Fundus photo:
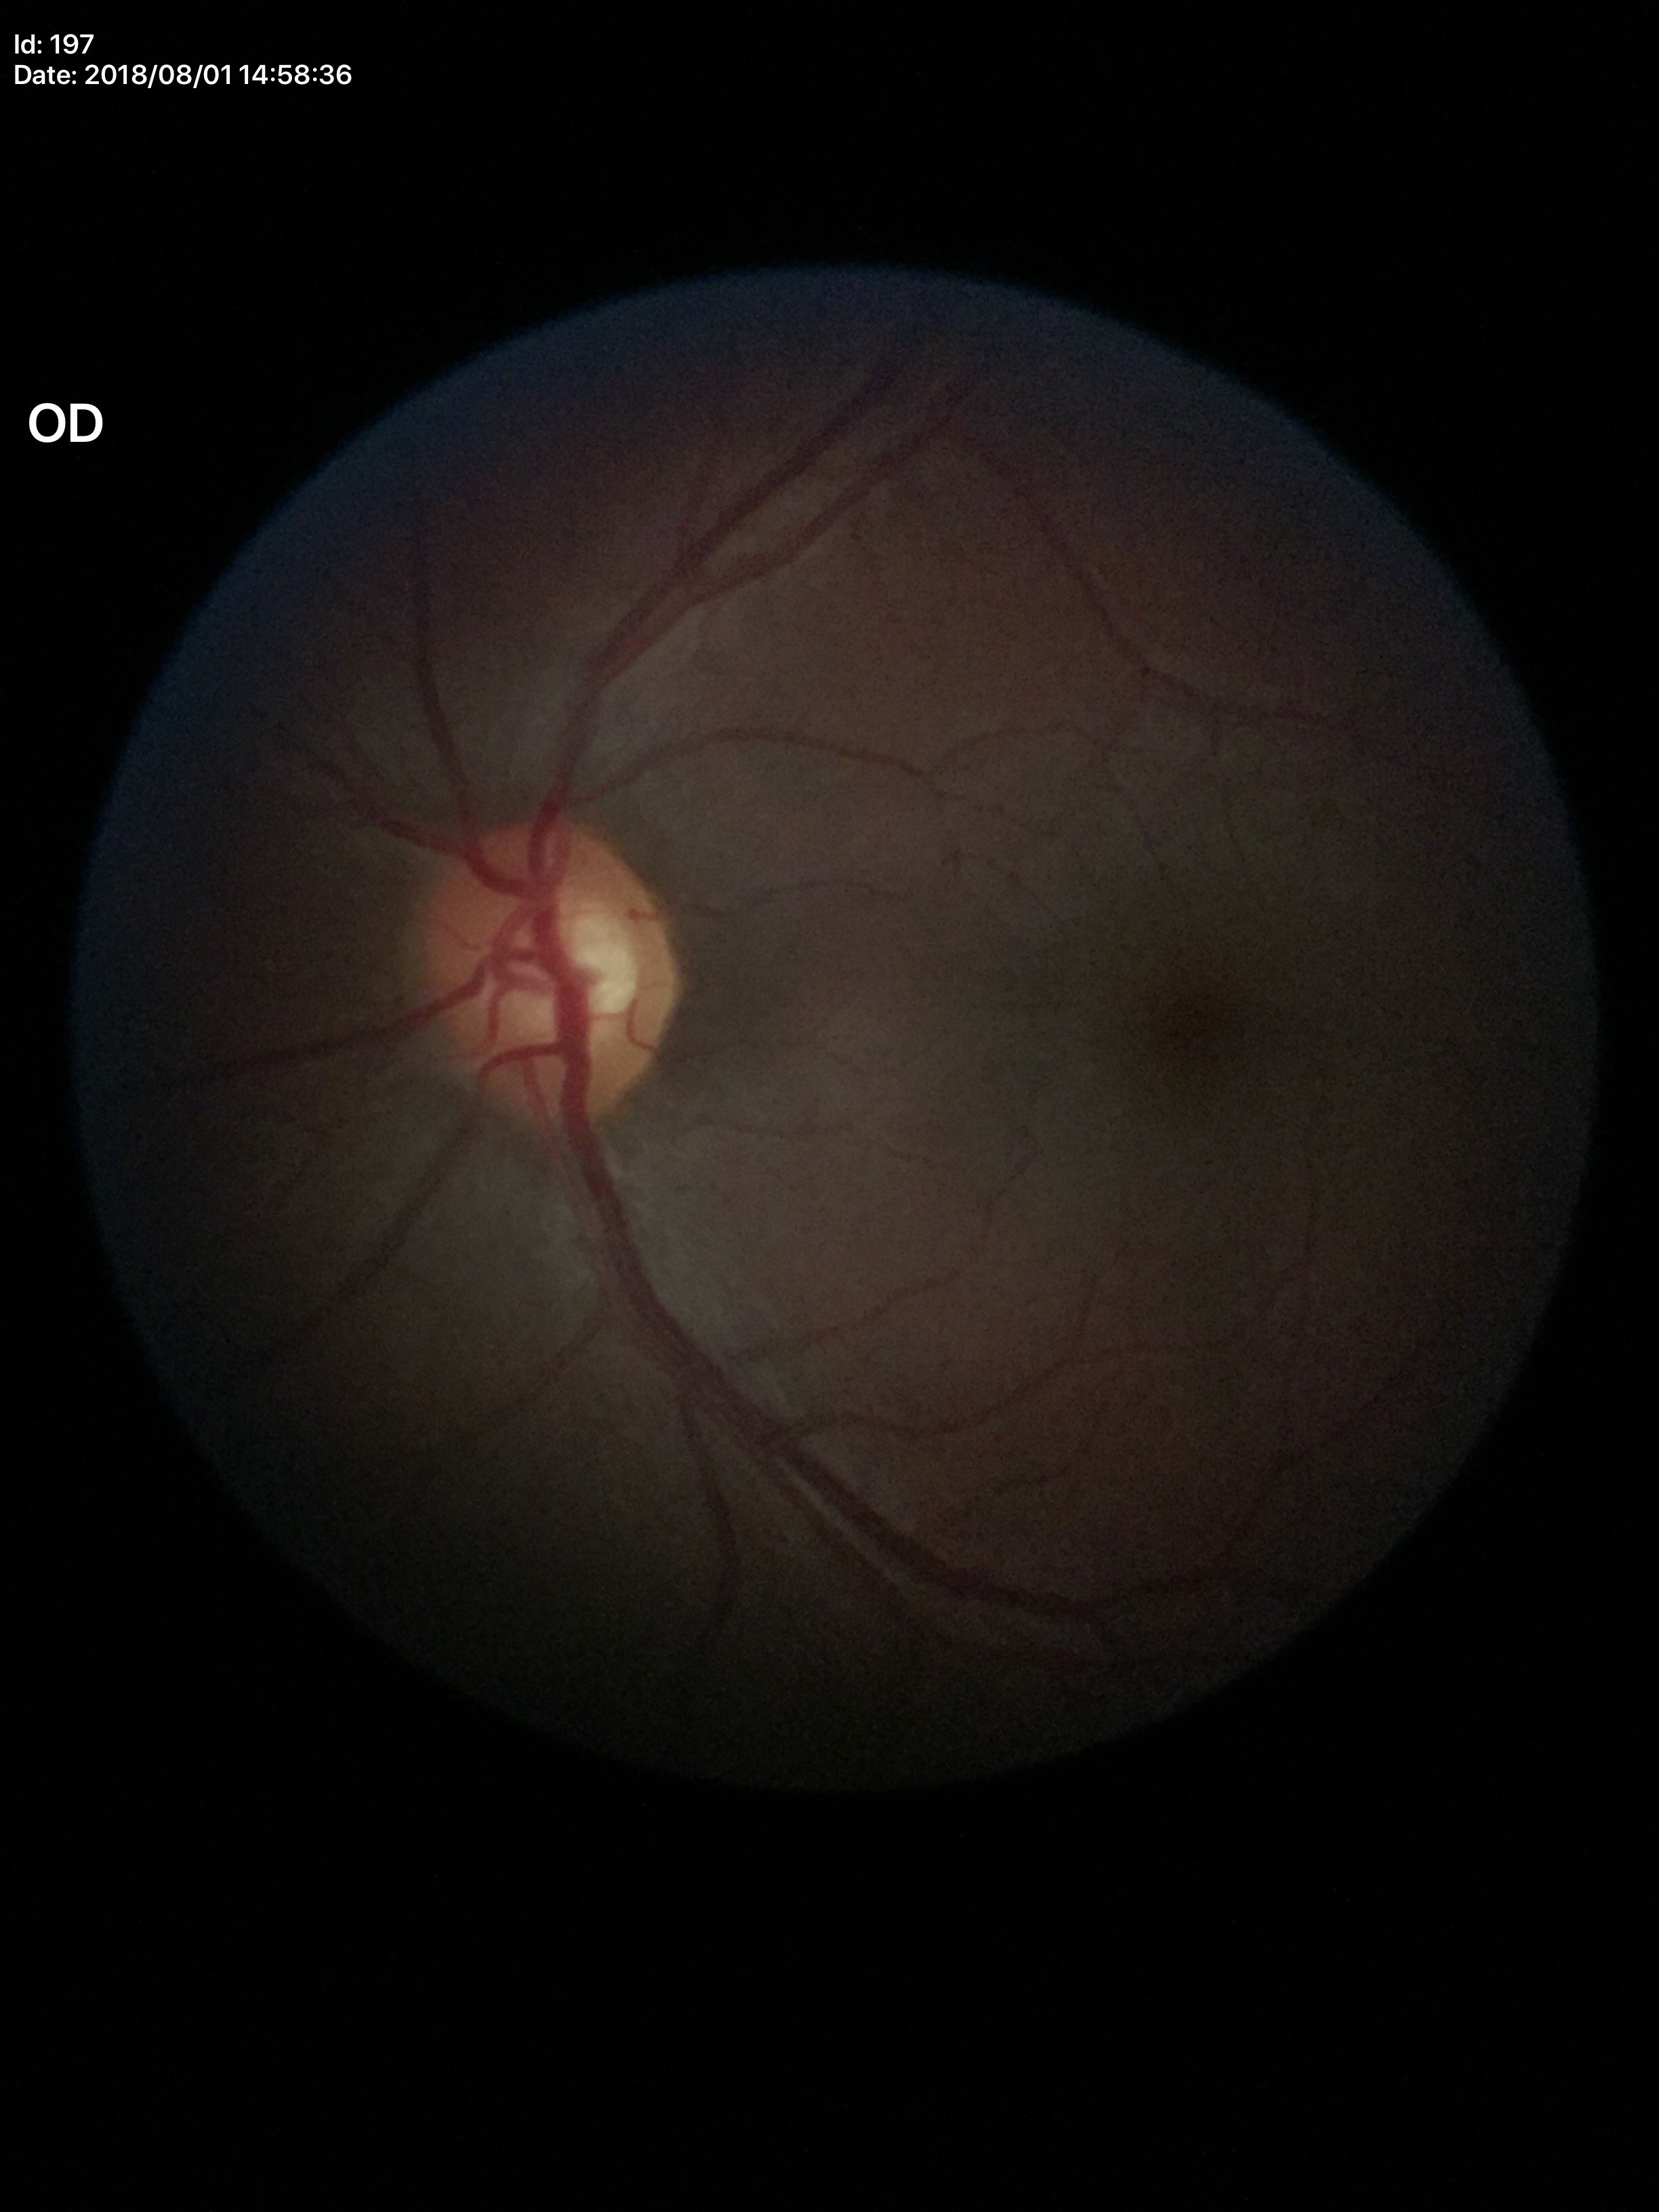
Glaucoma impression=negative | horizontal CDR=0.65 | vertical C/D ratio=0.56